FOV: 45 degrees — 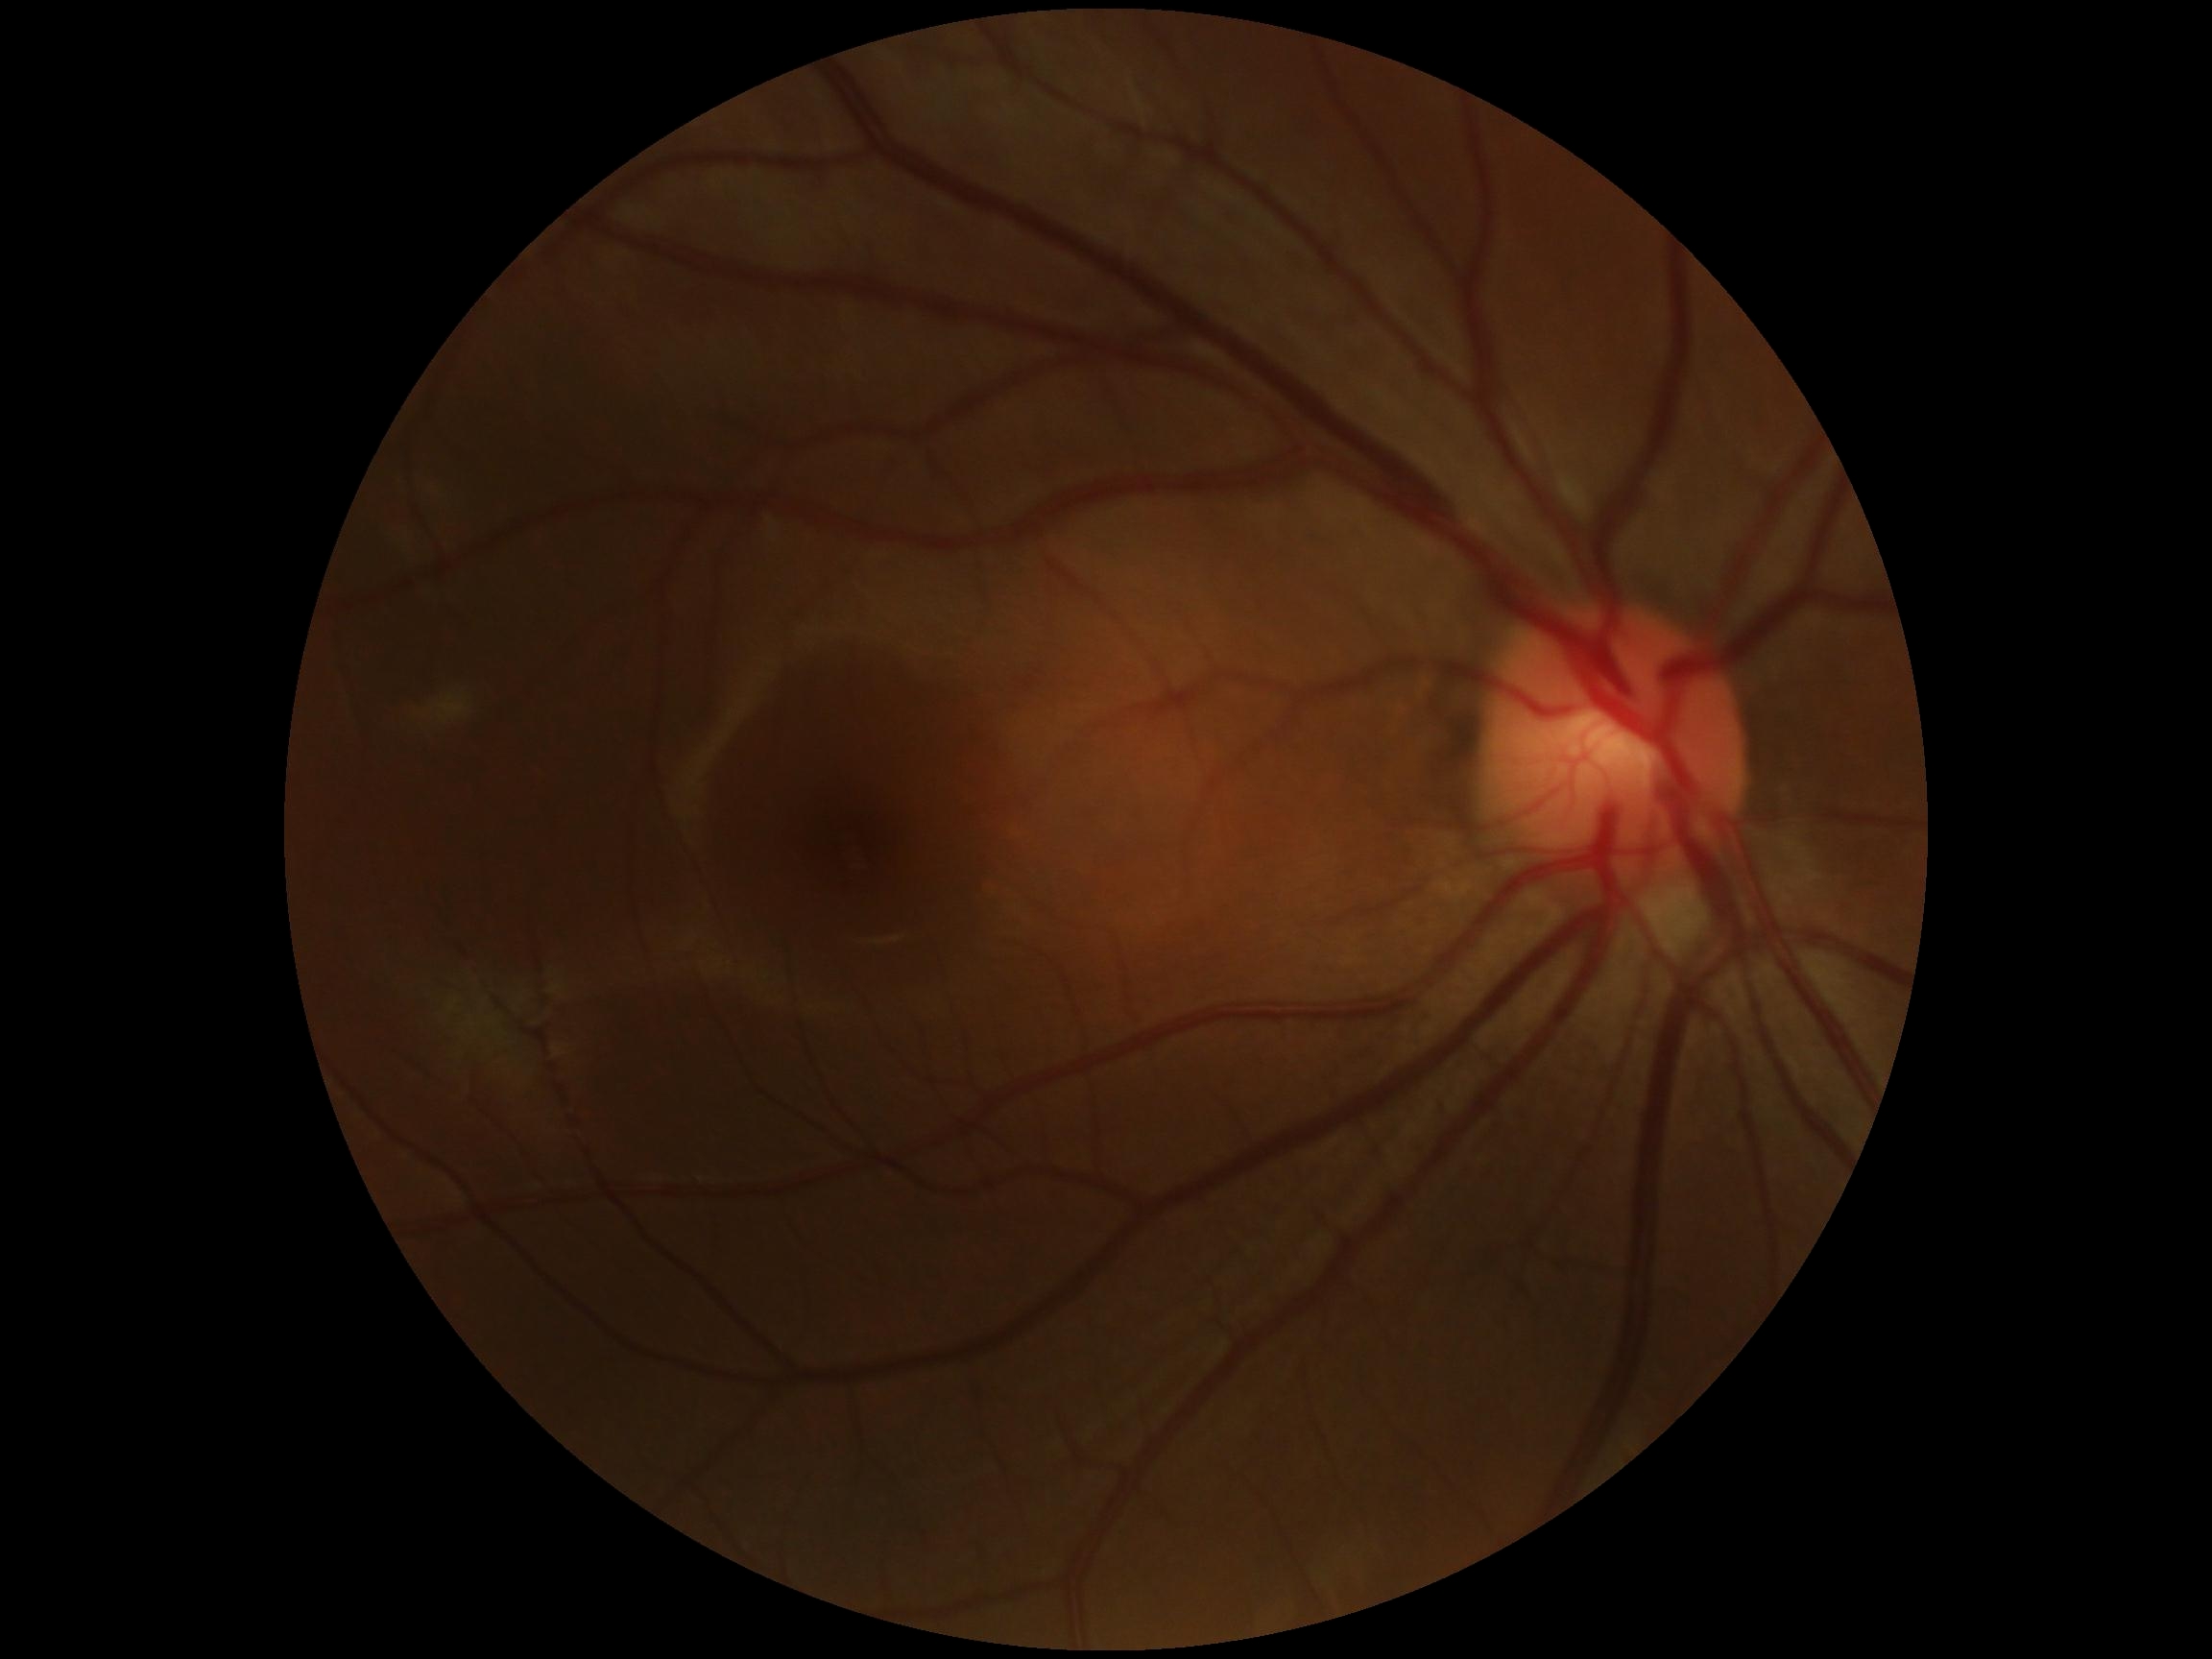 Diabetic retinopathy (DR): 0.